Infant wide-field fundus photograph · captured with the Phoenix ICON (100° field of view) — 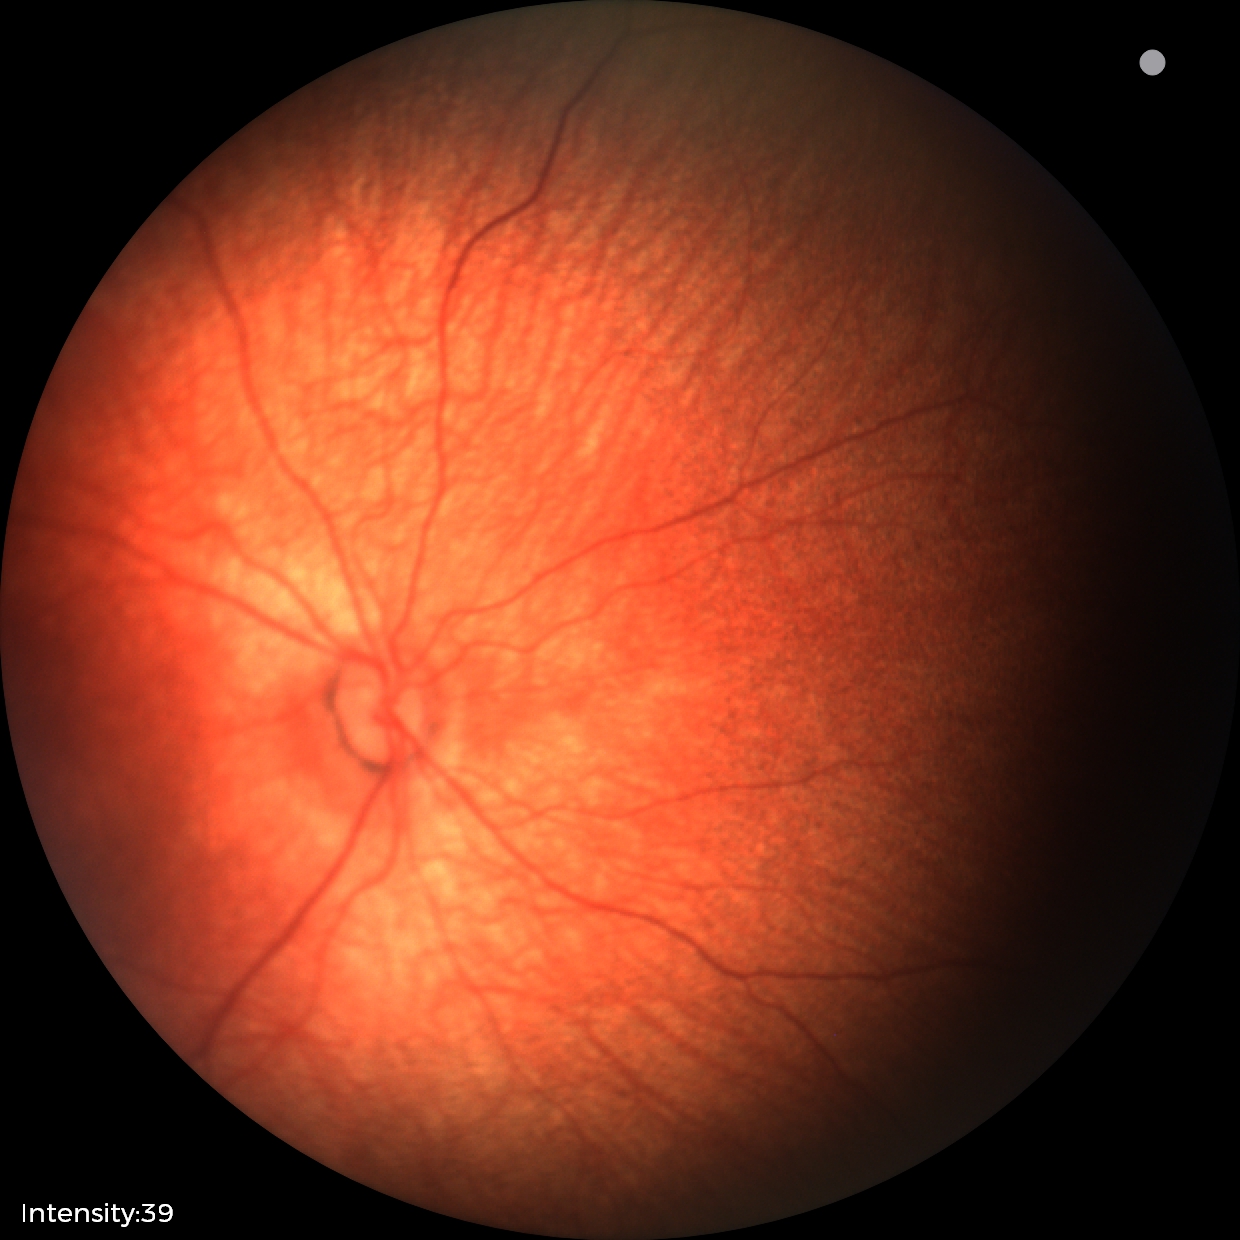 Examination with physiological retinal findings.